RetCam wide-field infant fundus image: 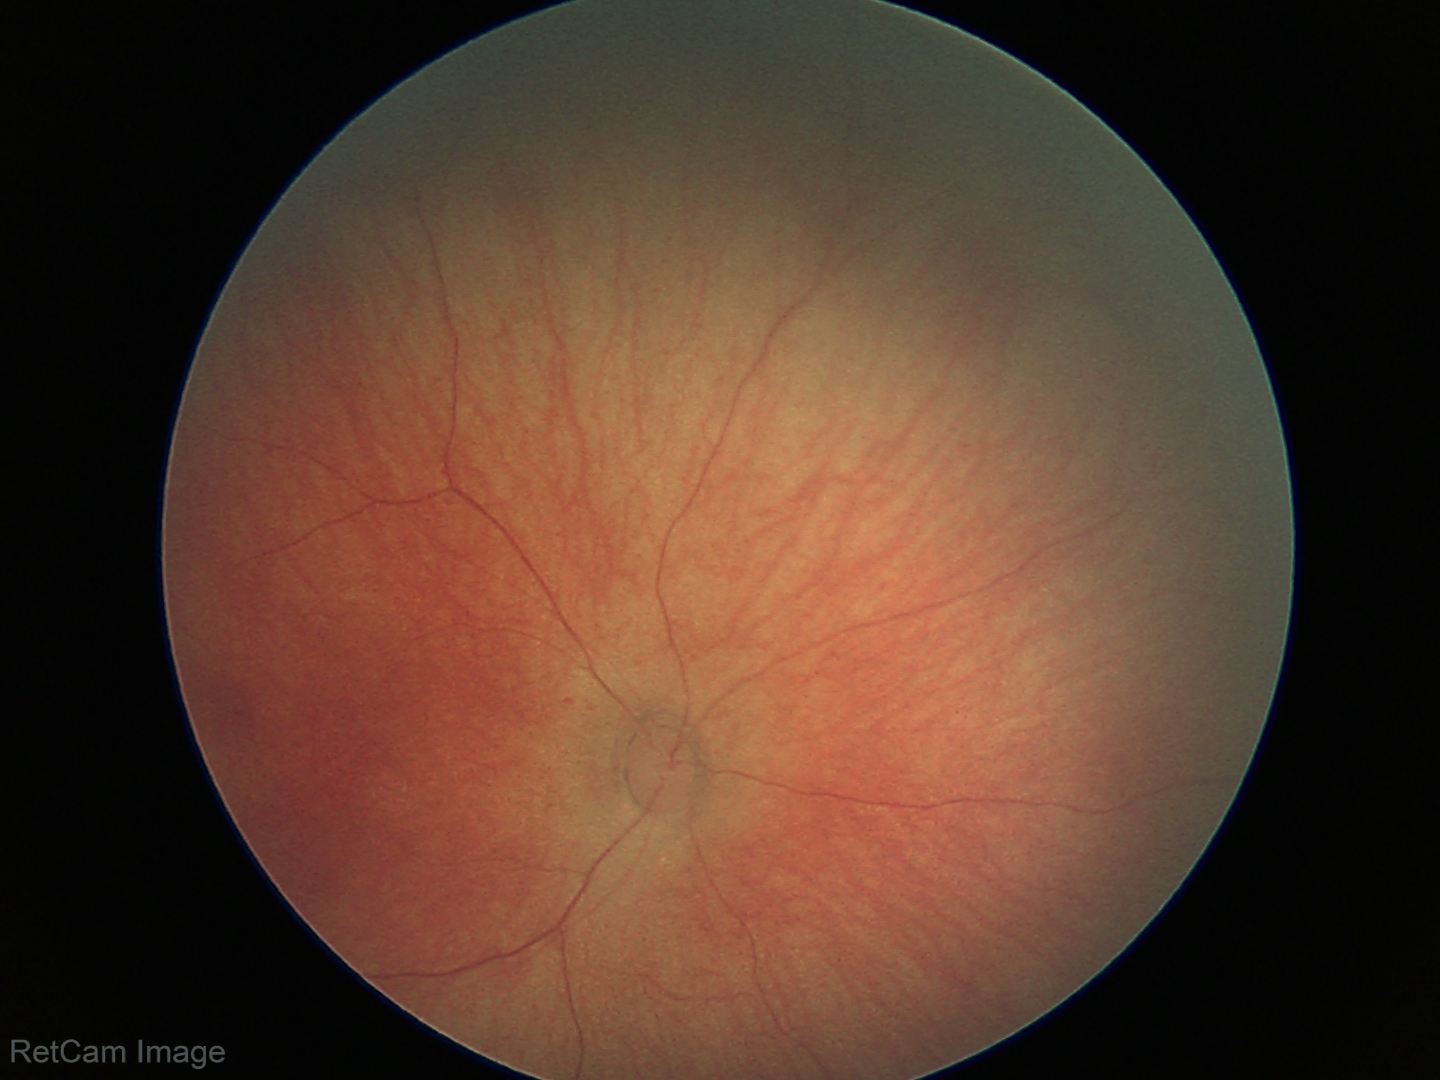

Screening: no abnormal retinal findings.